Modified Davis classification: 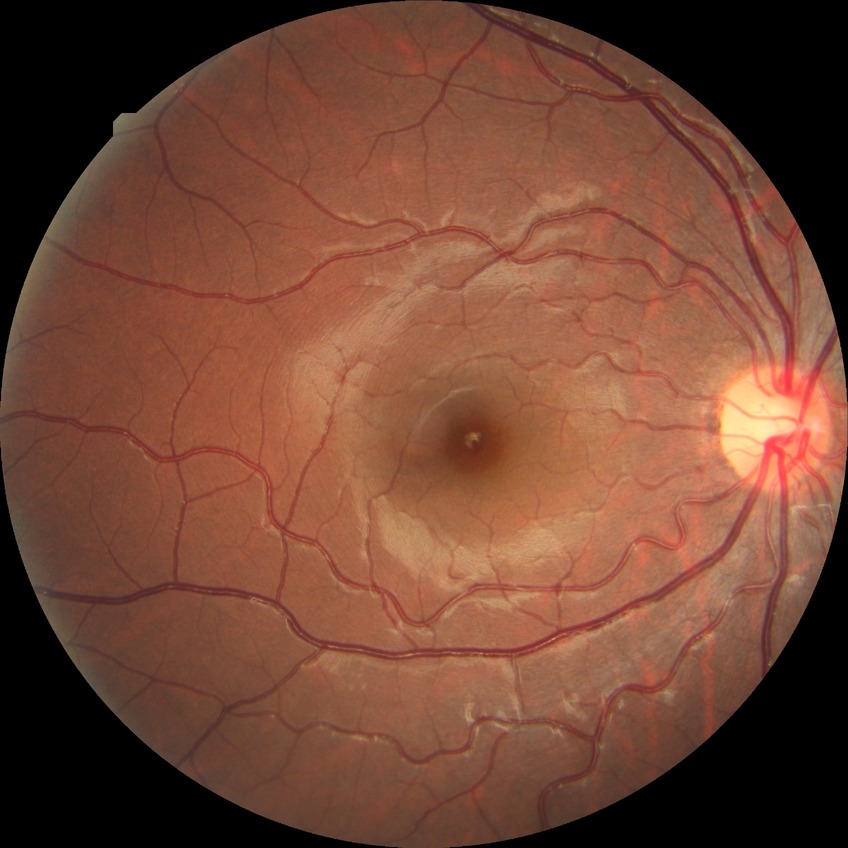
diabetic retinopathy (DR)@no diabetic retinopathy (NDR).